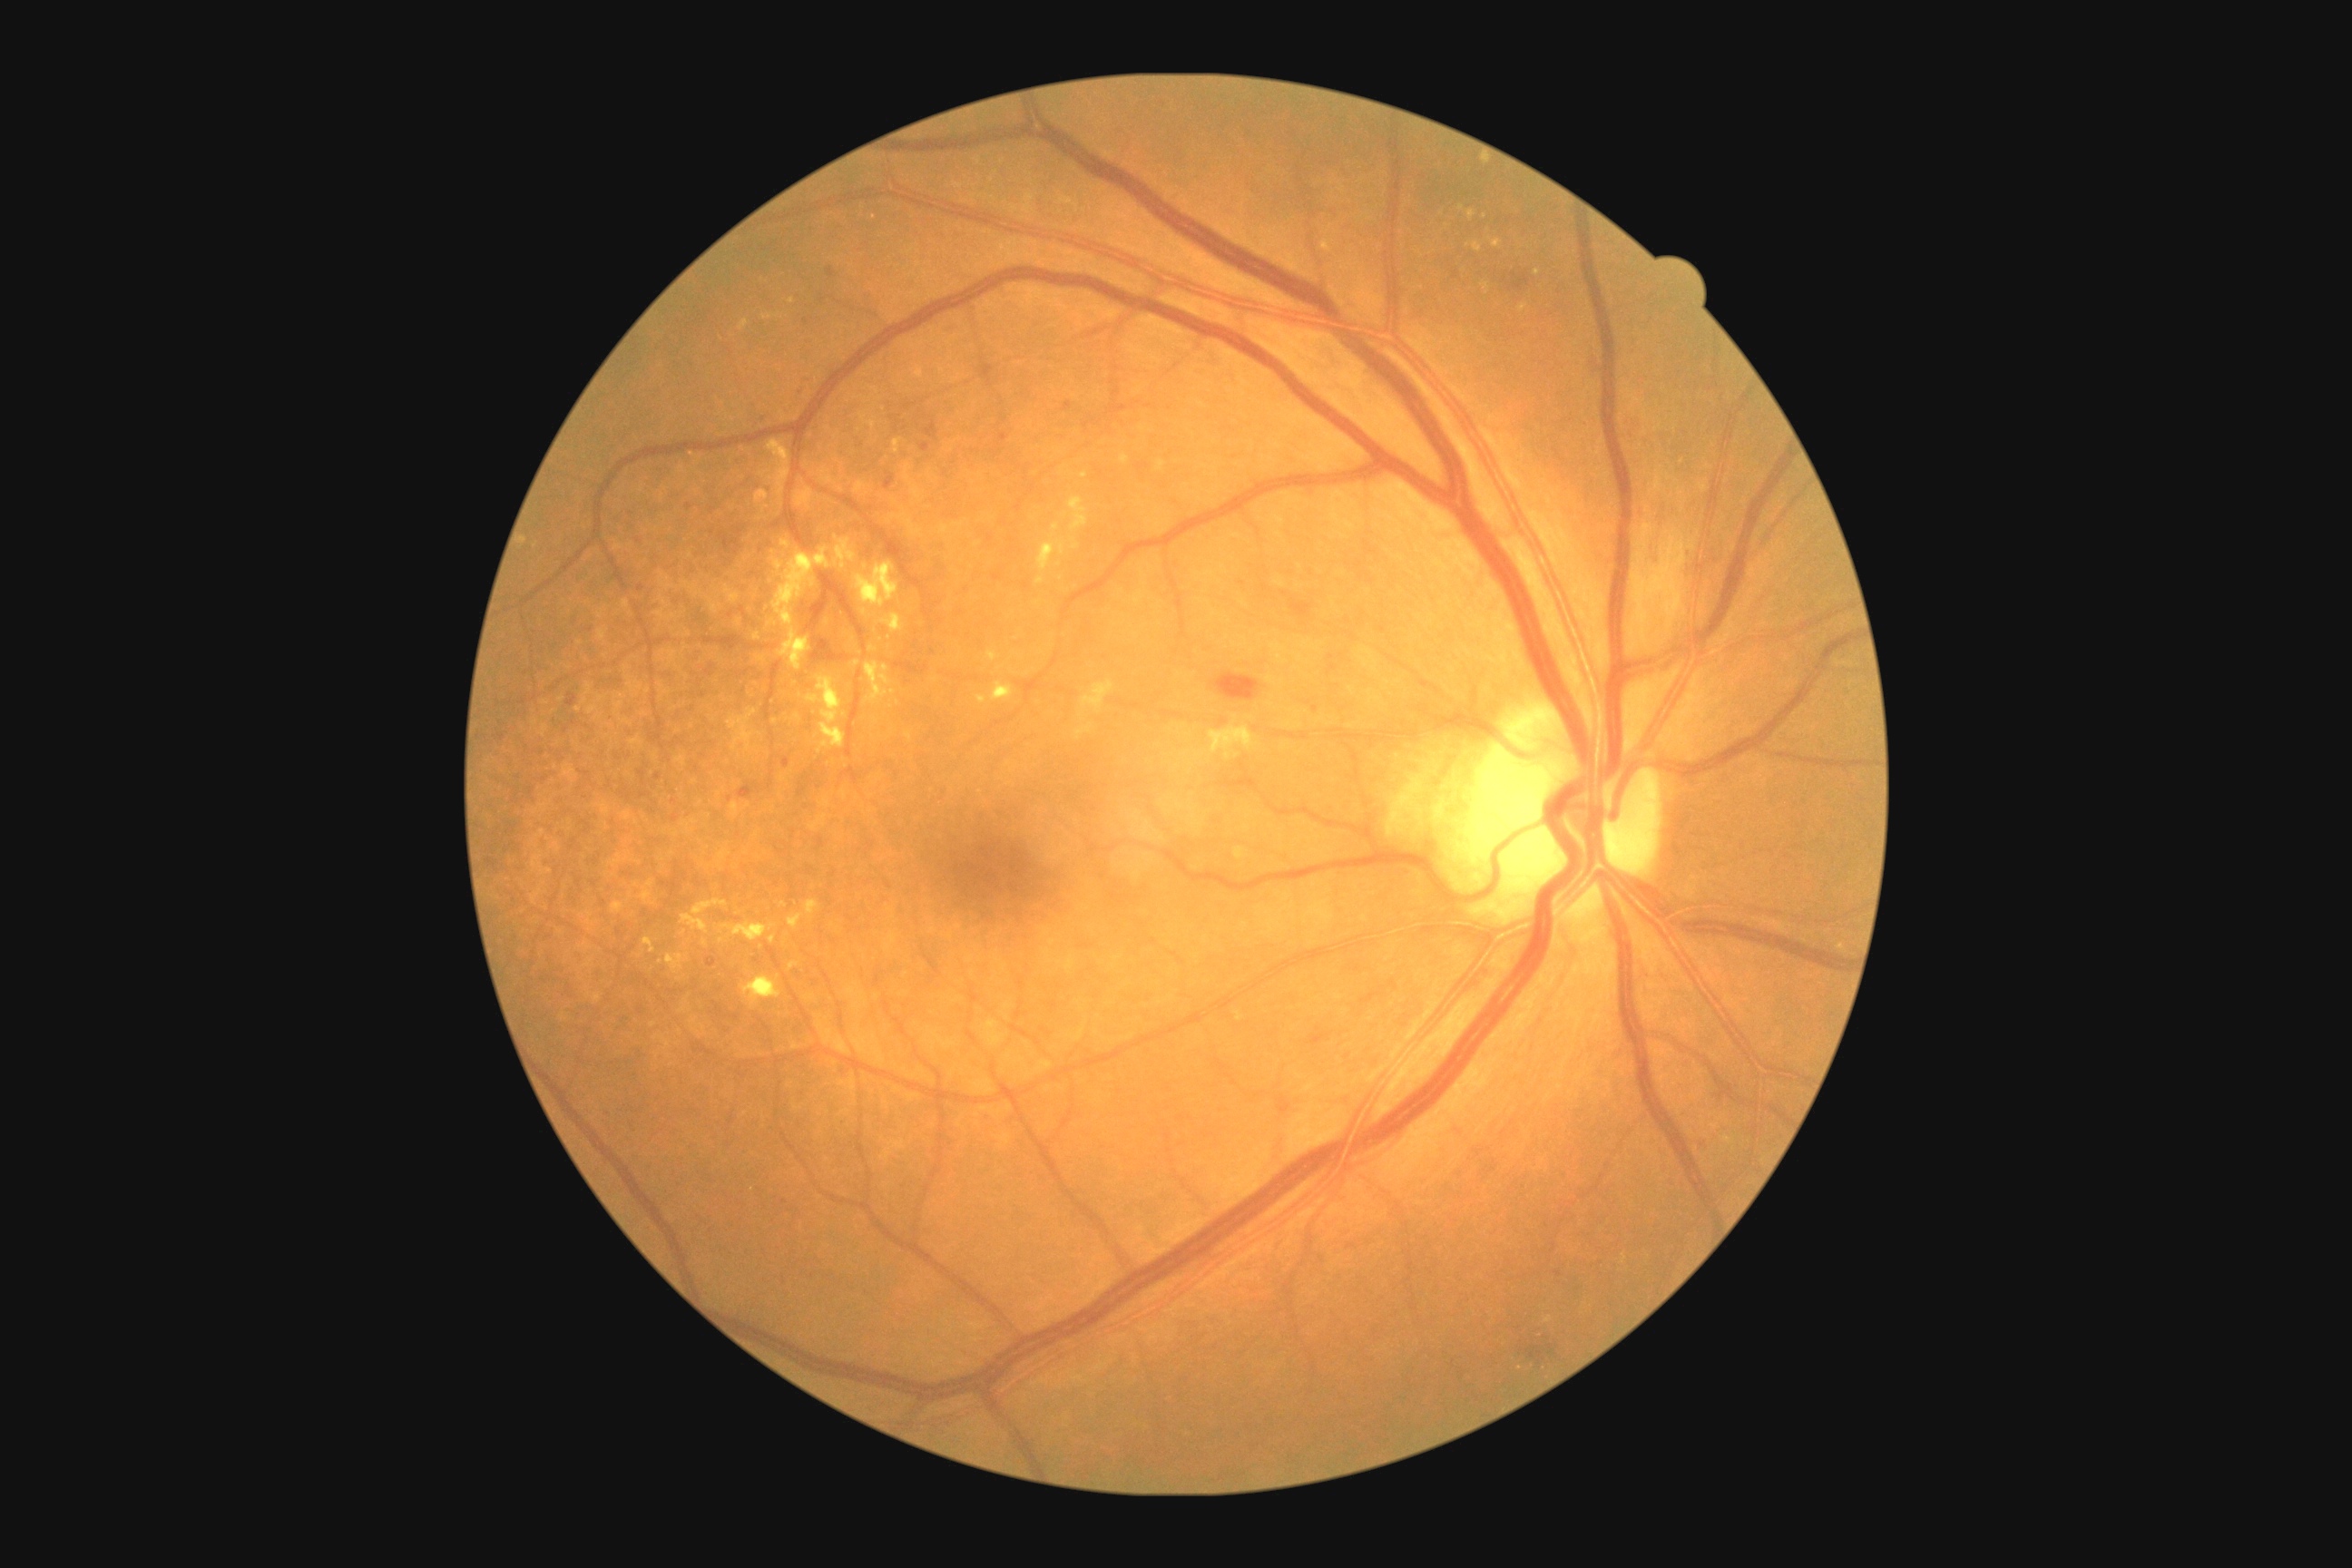 Disease class: non-proliferative diabetic retinopathy.
DR: 2.